FOV: 45 degrees. 2352x1568px. Retinal fundus photograph: 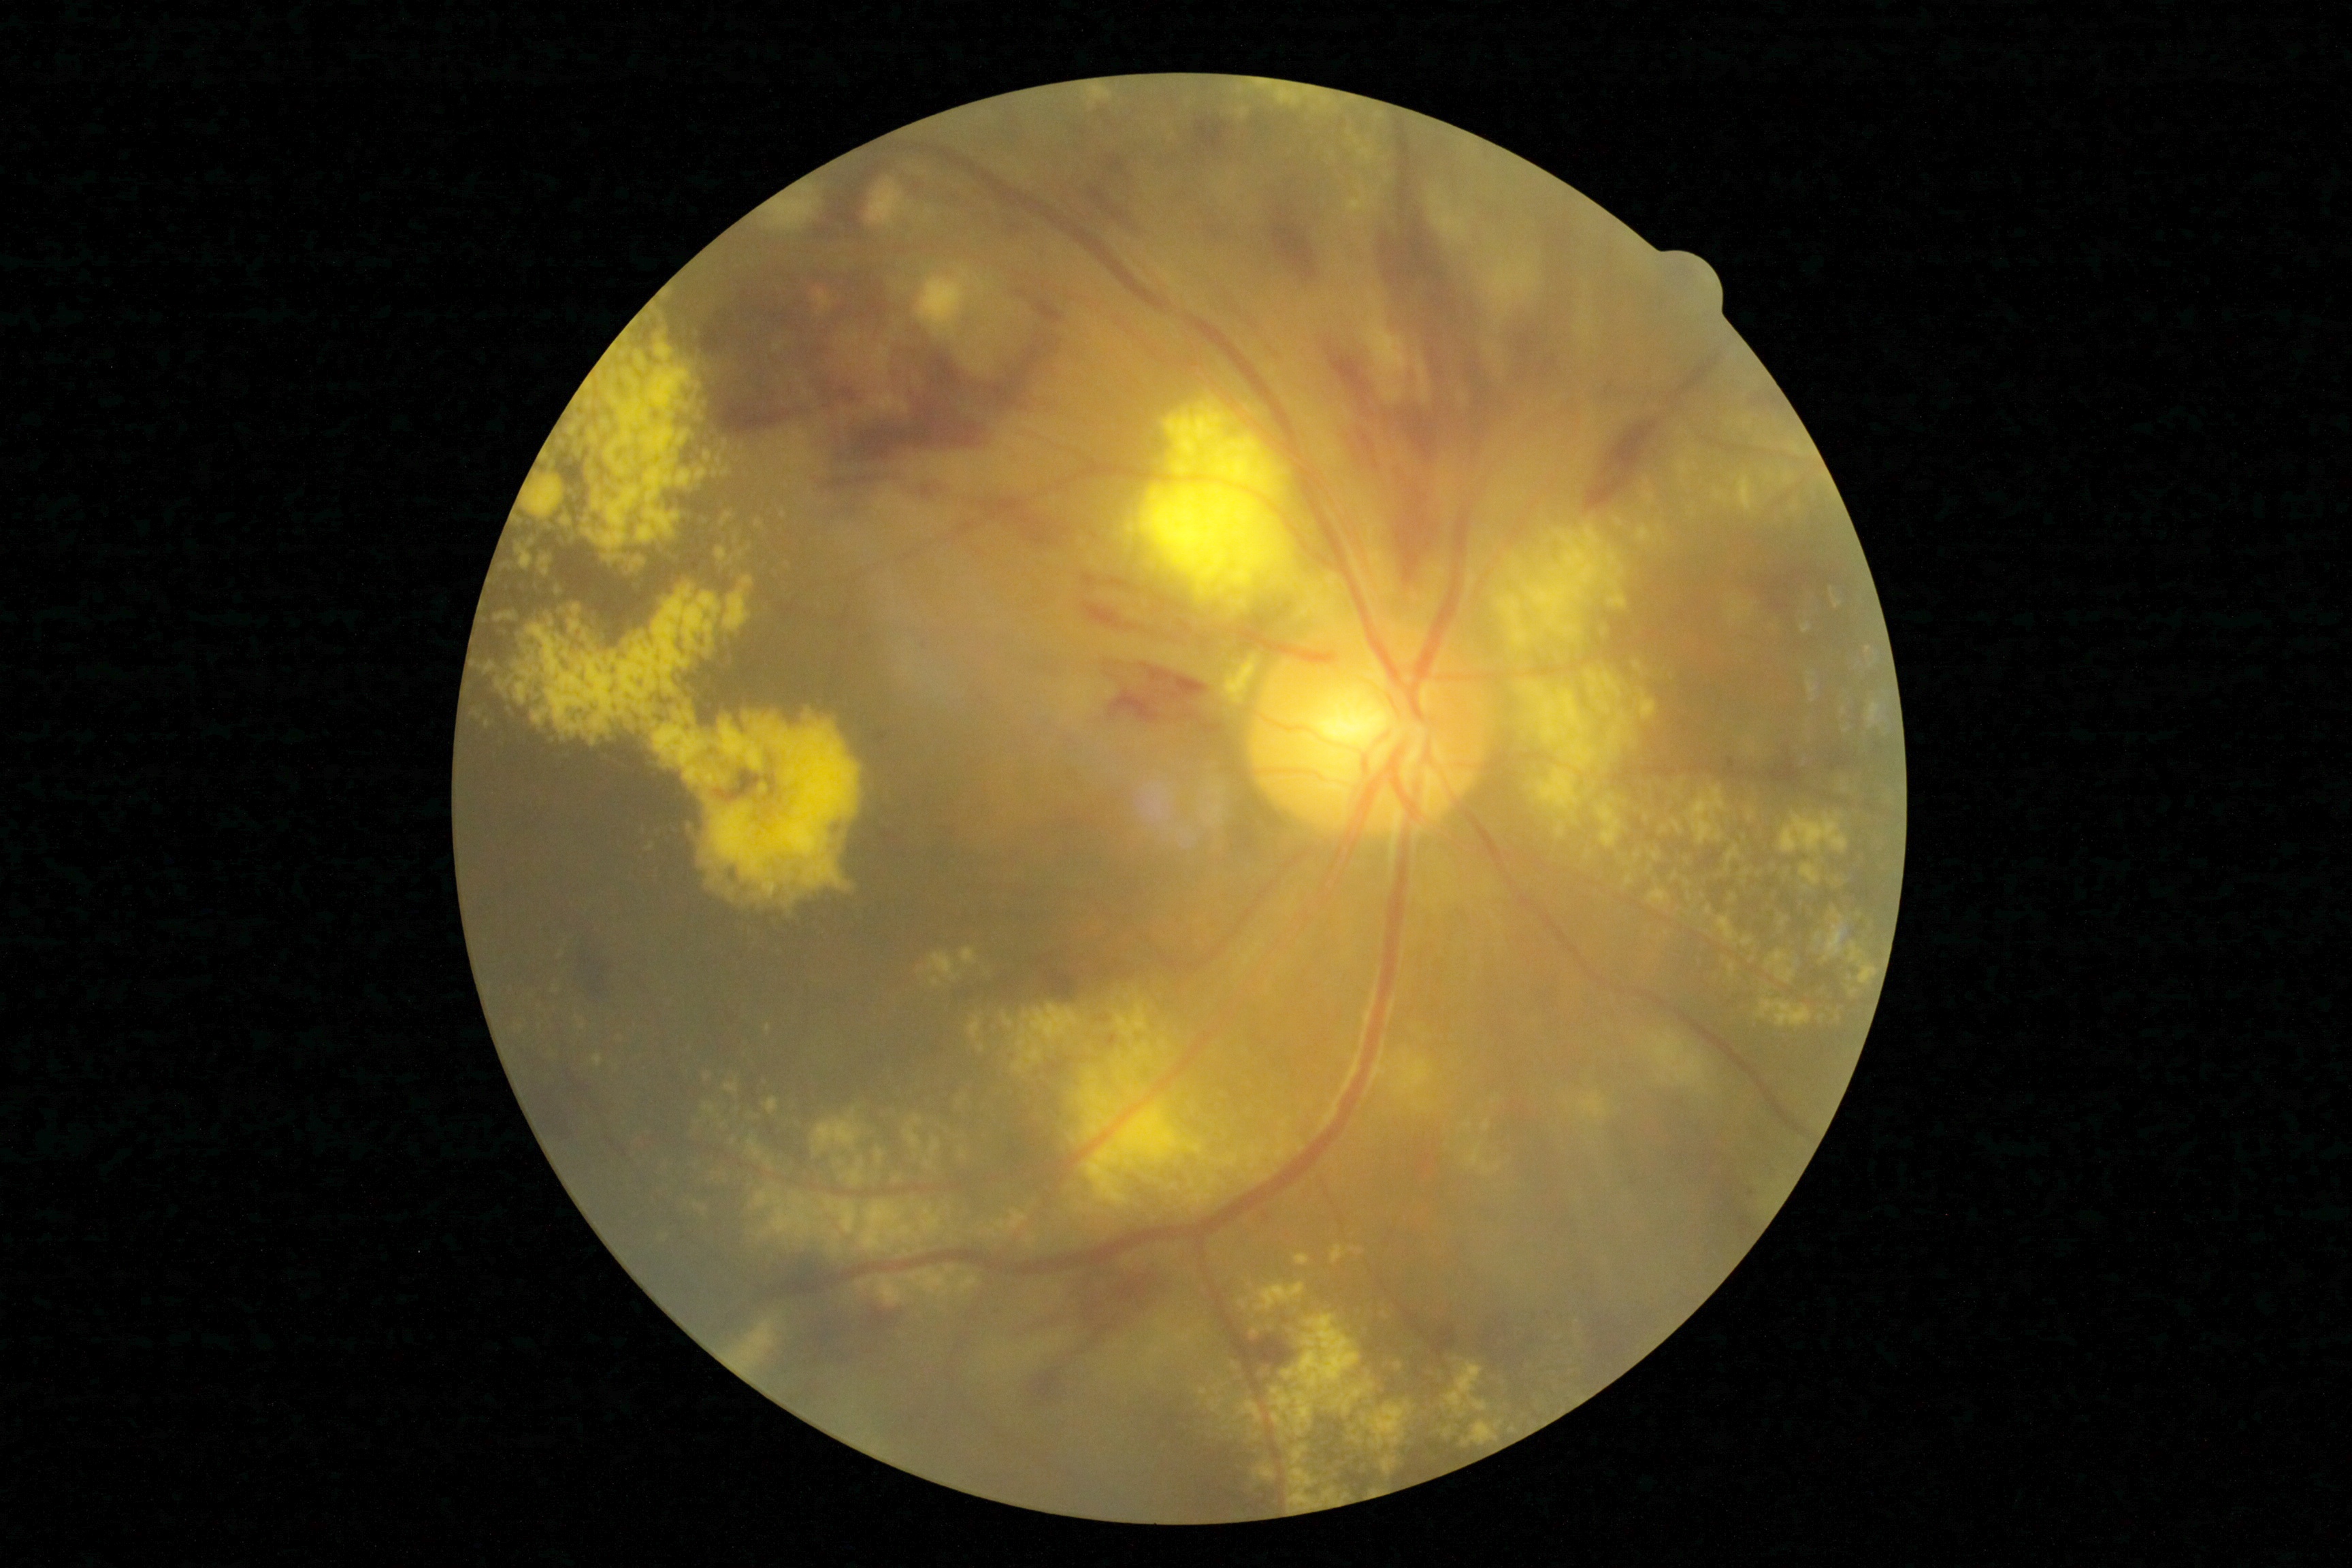 DR severity is severe NPDR (grade 3) — more than 20 intraretinal hemorrhages in each of 4 quadrants, definite venous beading in 2 or more quadrants, or prominent intraretinal microvascular abnormalities in 1 or more quadrants, with no signs of proliferative retinopathy.